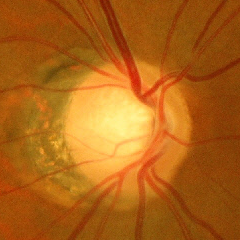

Q: What is the glaucoma diagnosis?
A: Yes — early glaucomatous optic neuropathy. (Criteria: glaucomatous retinal nerve fiber layer defects on red-free fundus photography without visual field defects.)